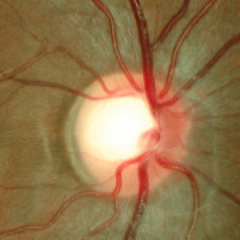
Glaucomatous changes are present. Diagnosis = early-stage glaucoma.